Acquired with a NIDEK AFC-230 · FOV: 45 degrees · modified Davis classification: 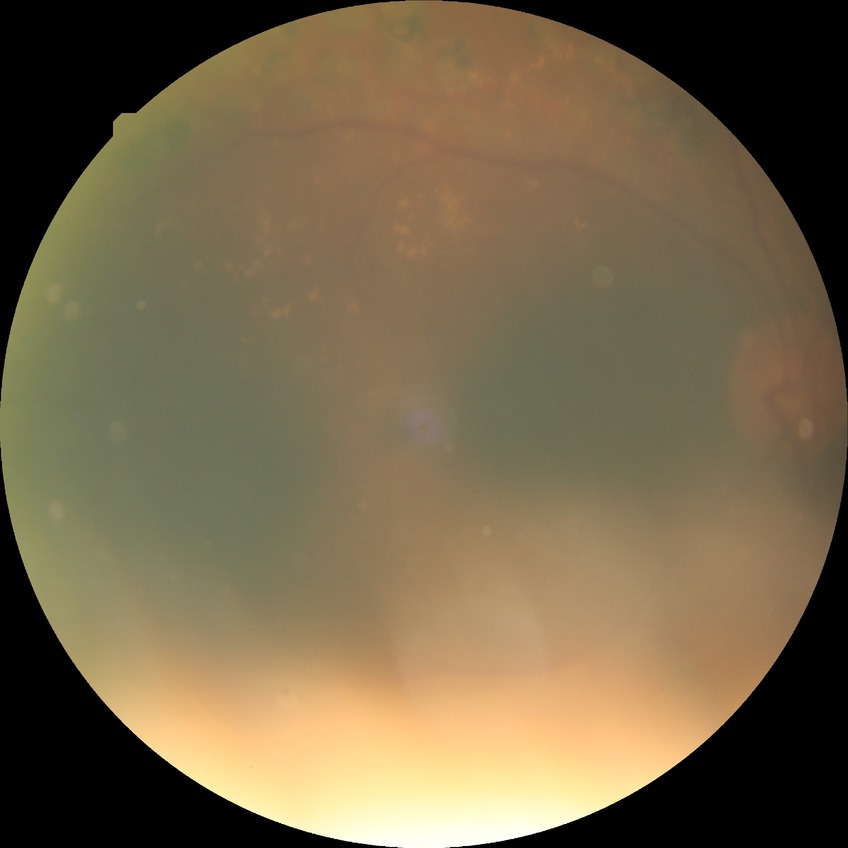
Davis stage: PDR.